CFP · acquired with a NIDEK AFC-230
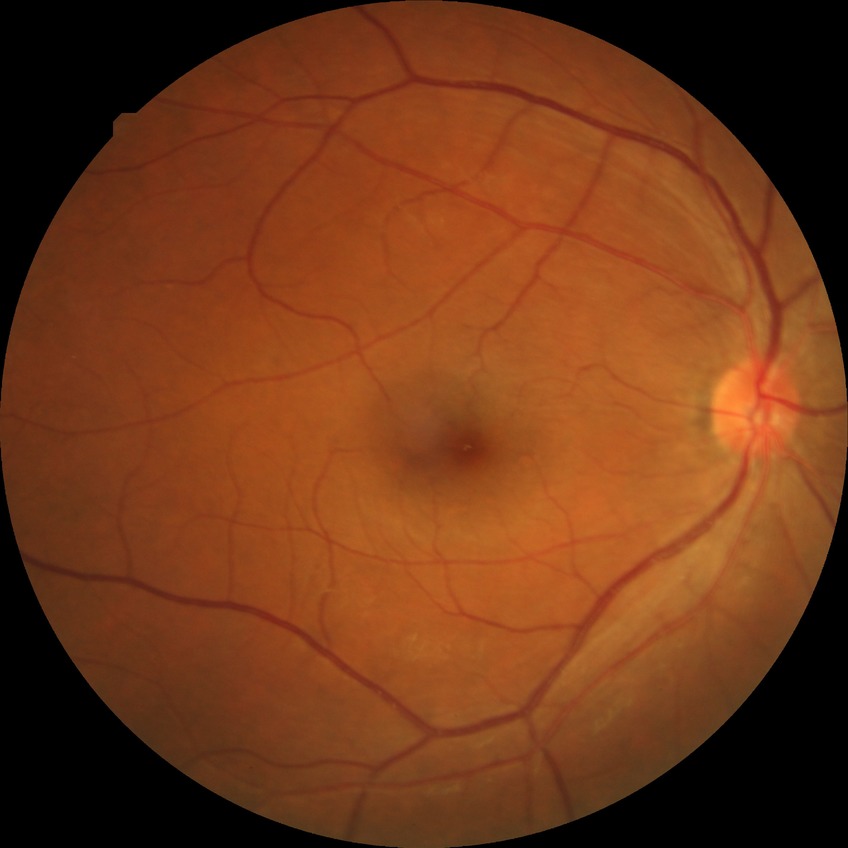

Diabetic retinopathy (DR): no diabetic retinopathy (NDR).